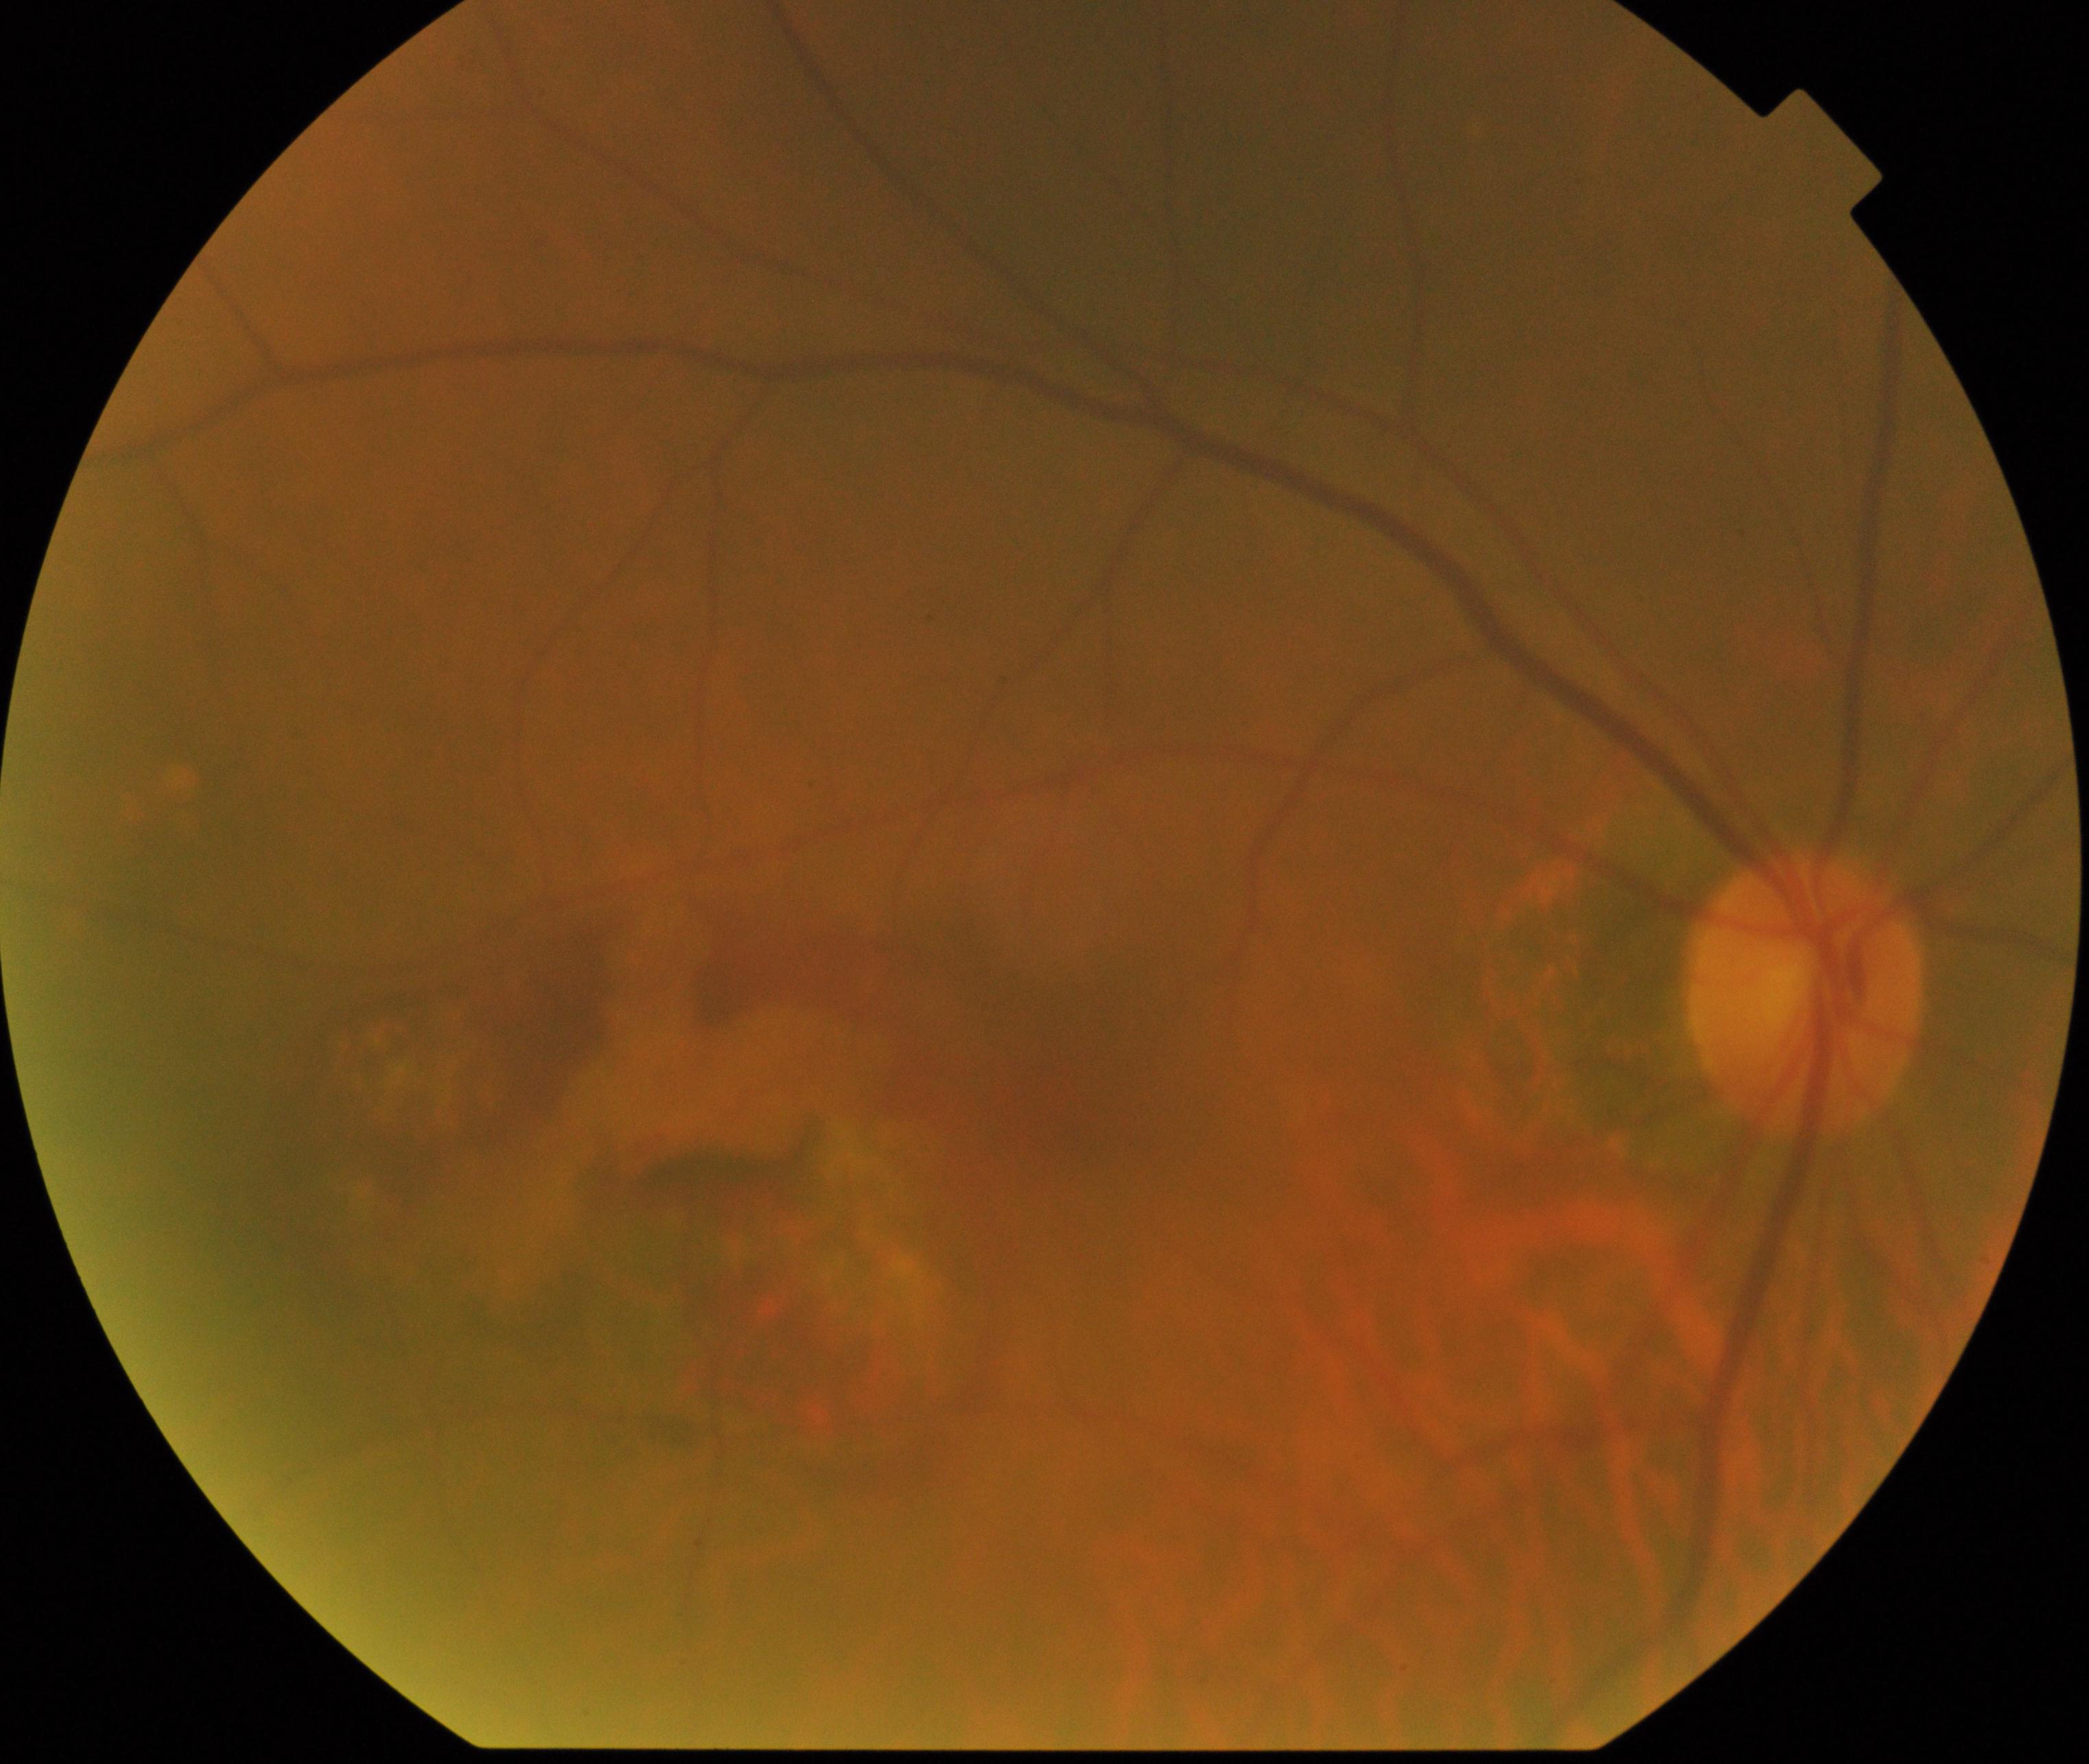
This fundus photograph shows maculopathy.